Color fundus photograph; 2089x1764 — 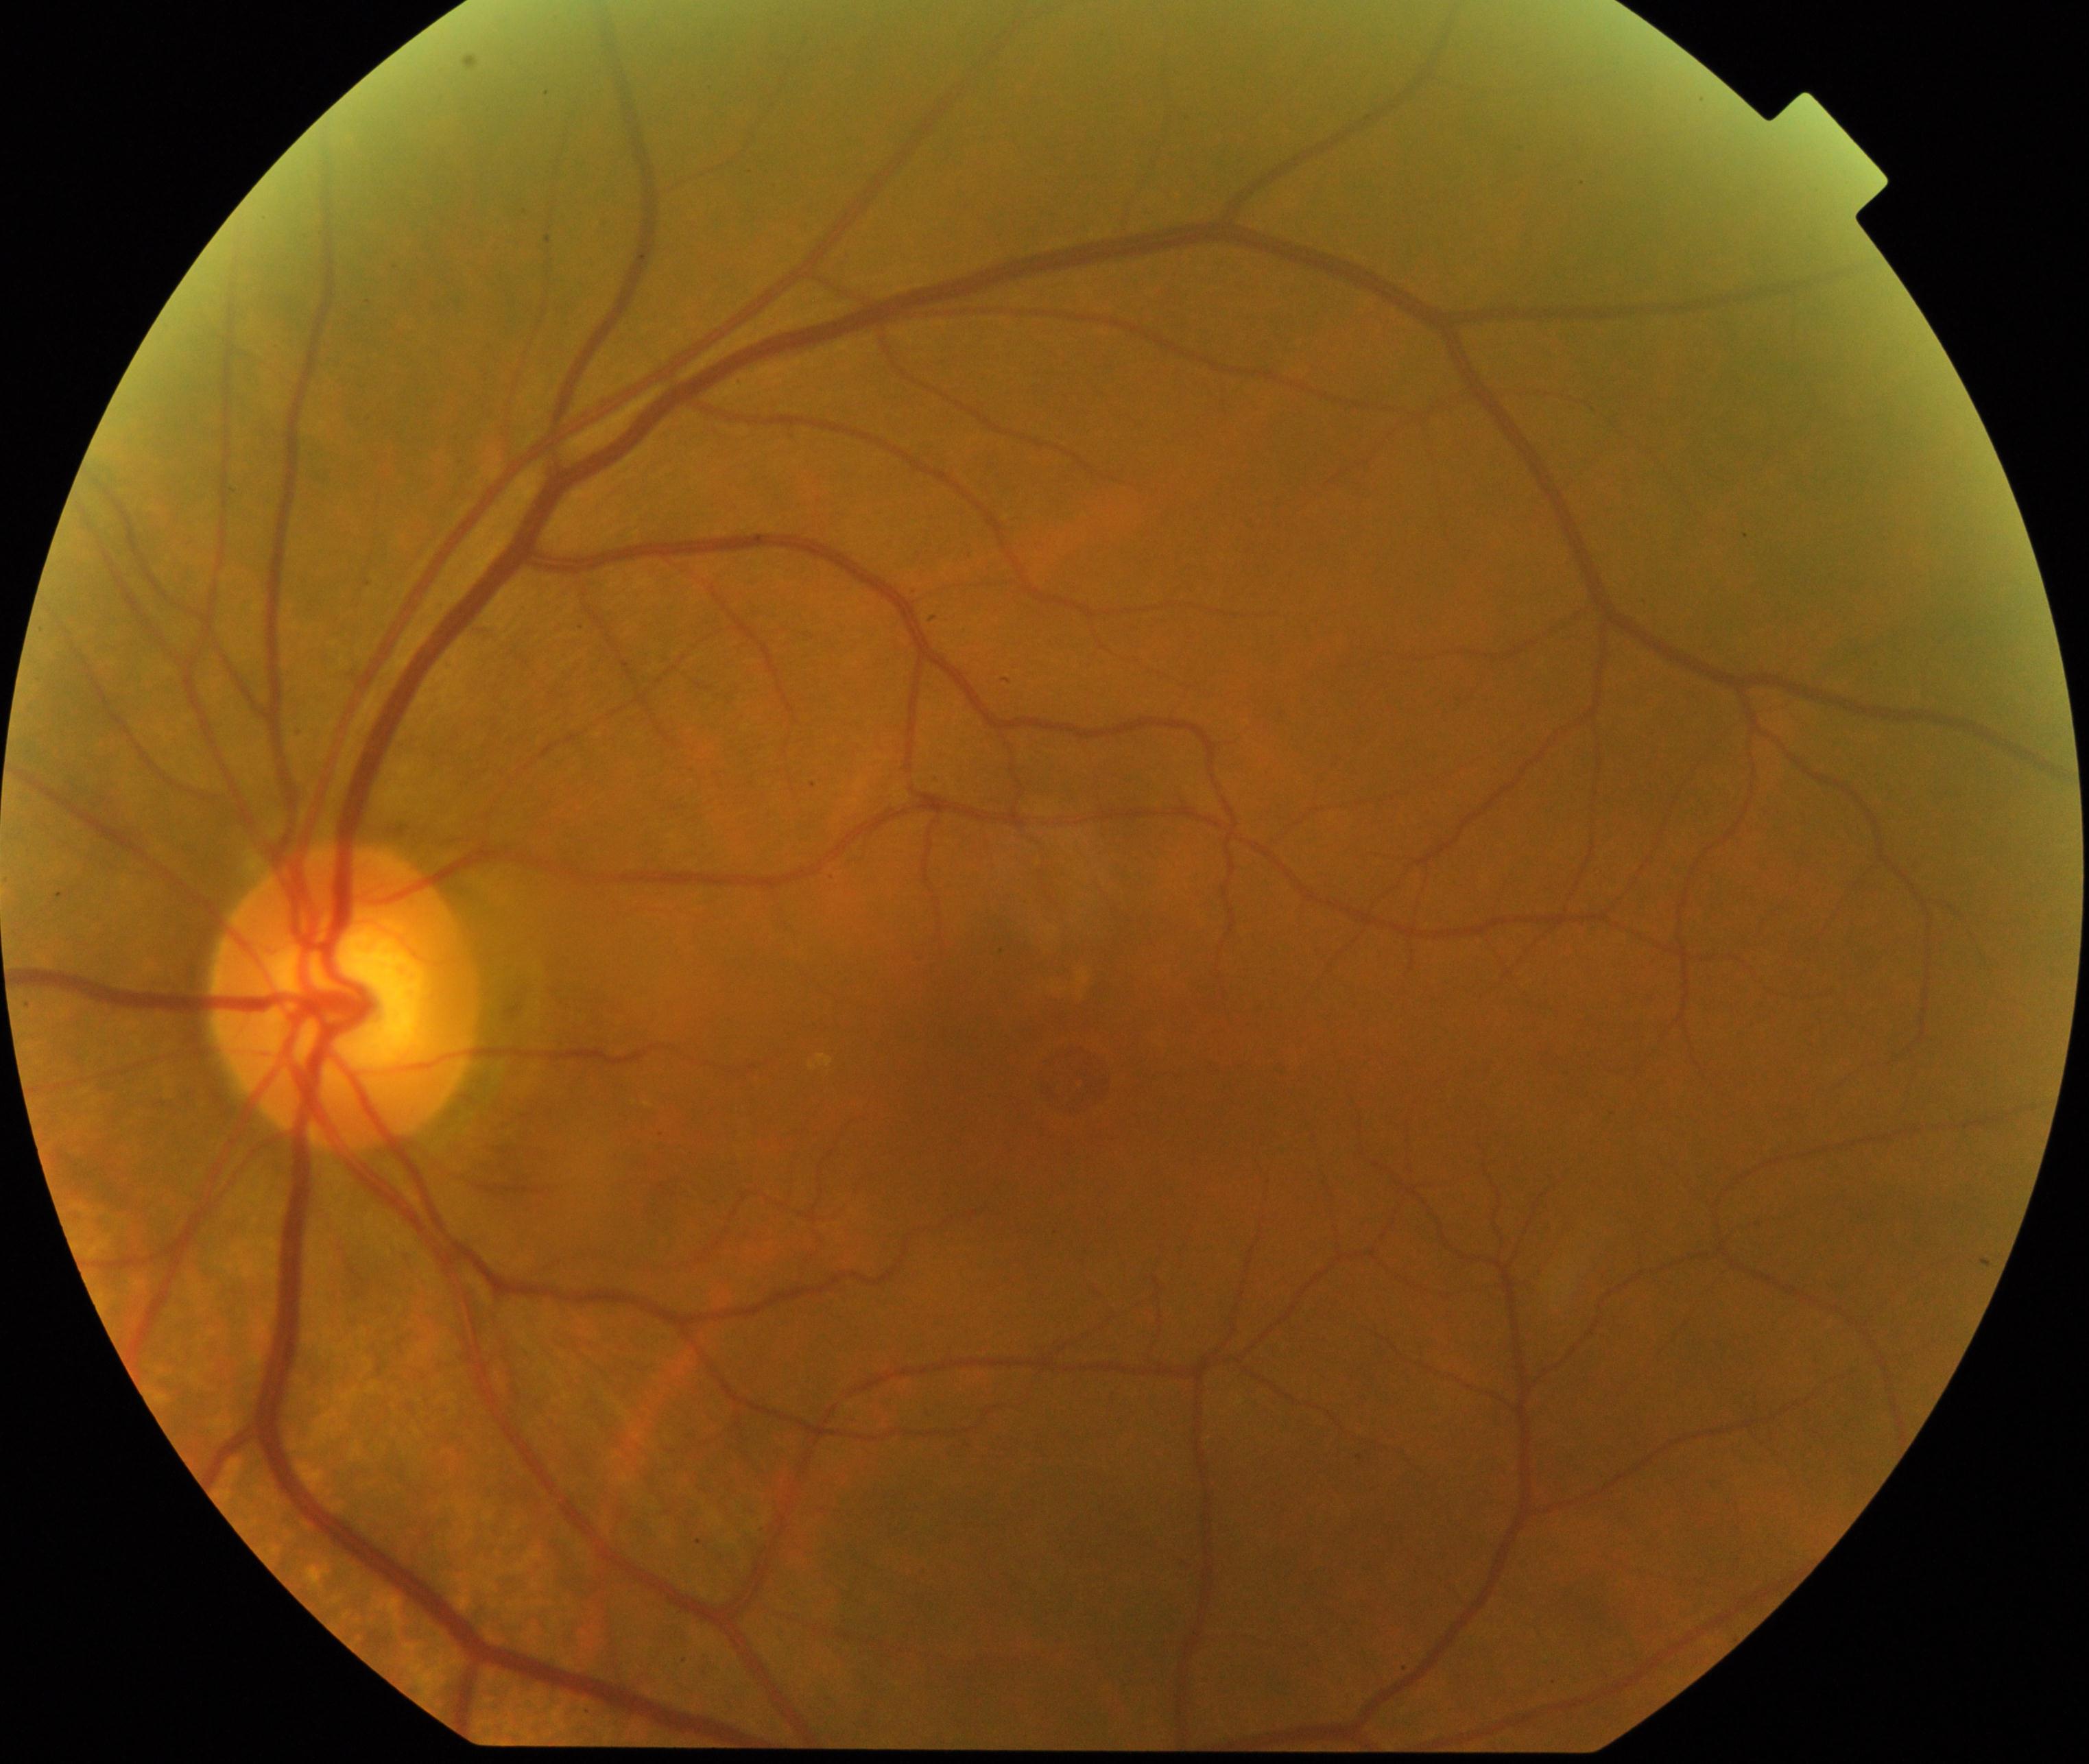
There is evidence of macular hole.